45-degree field of view · camera: NIDEK AFC-230: 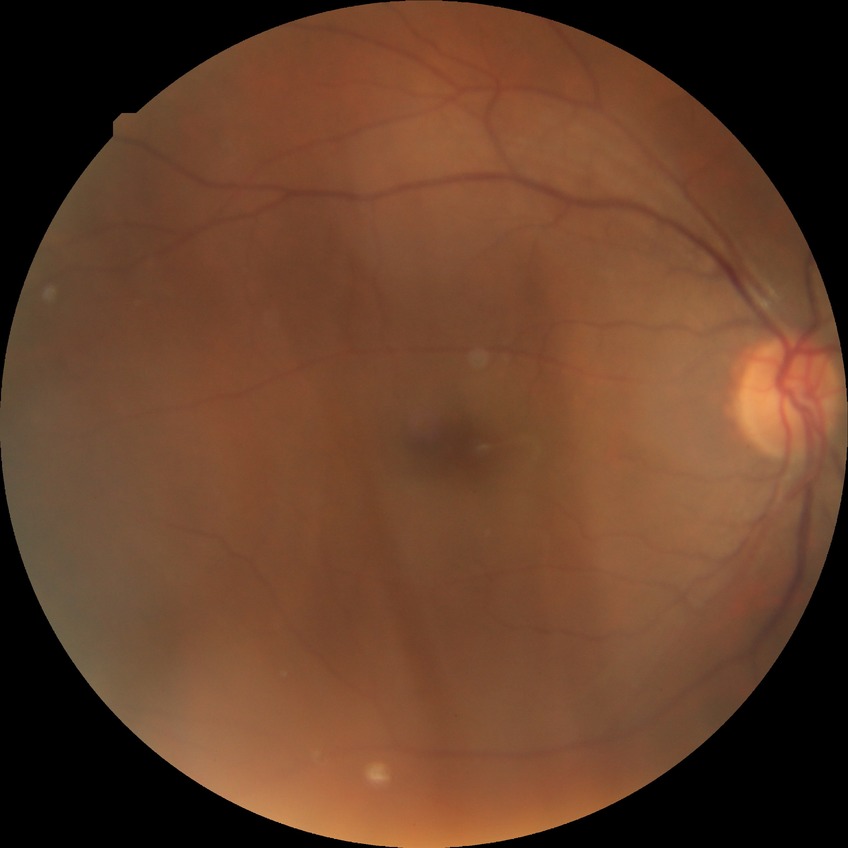
Diabetic retinopathy (DR): NDR (no diabetic retinopathy).